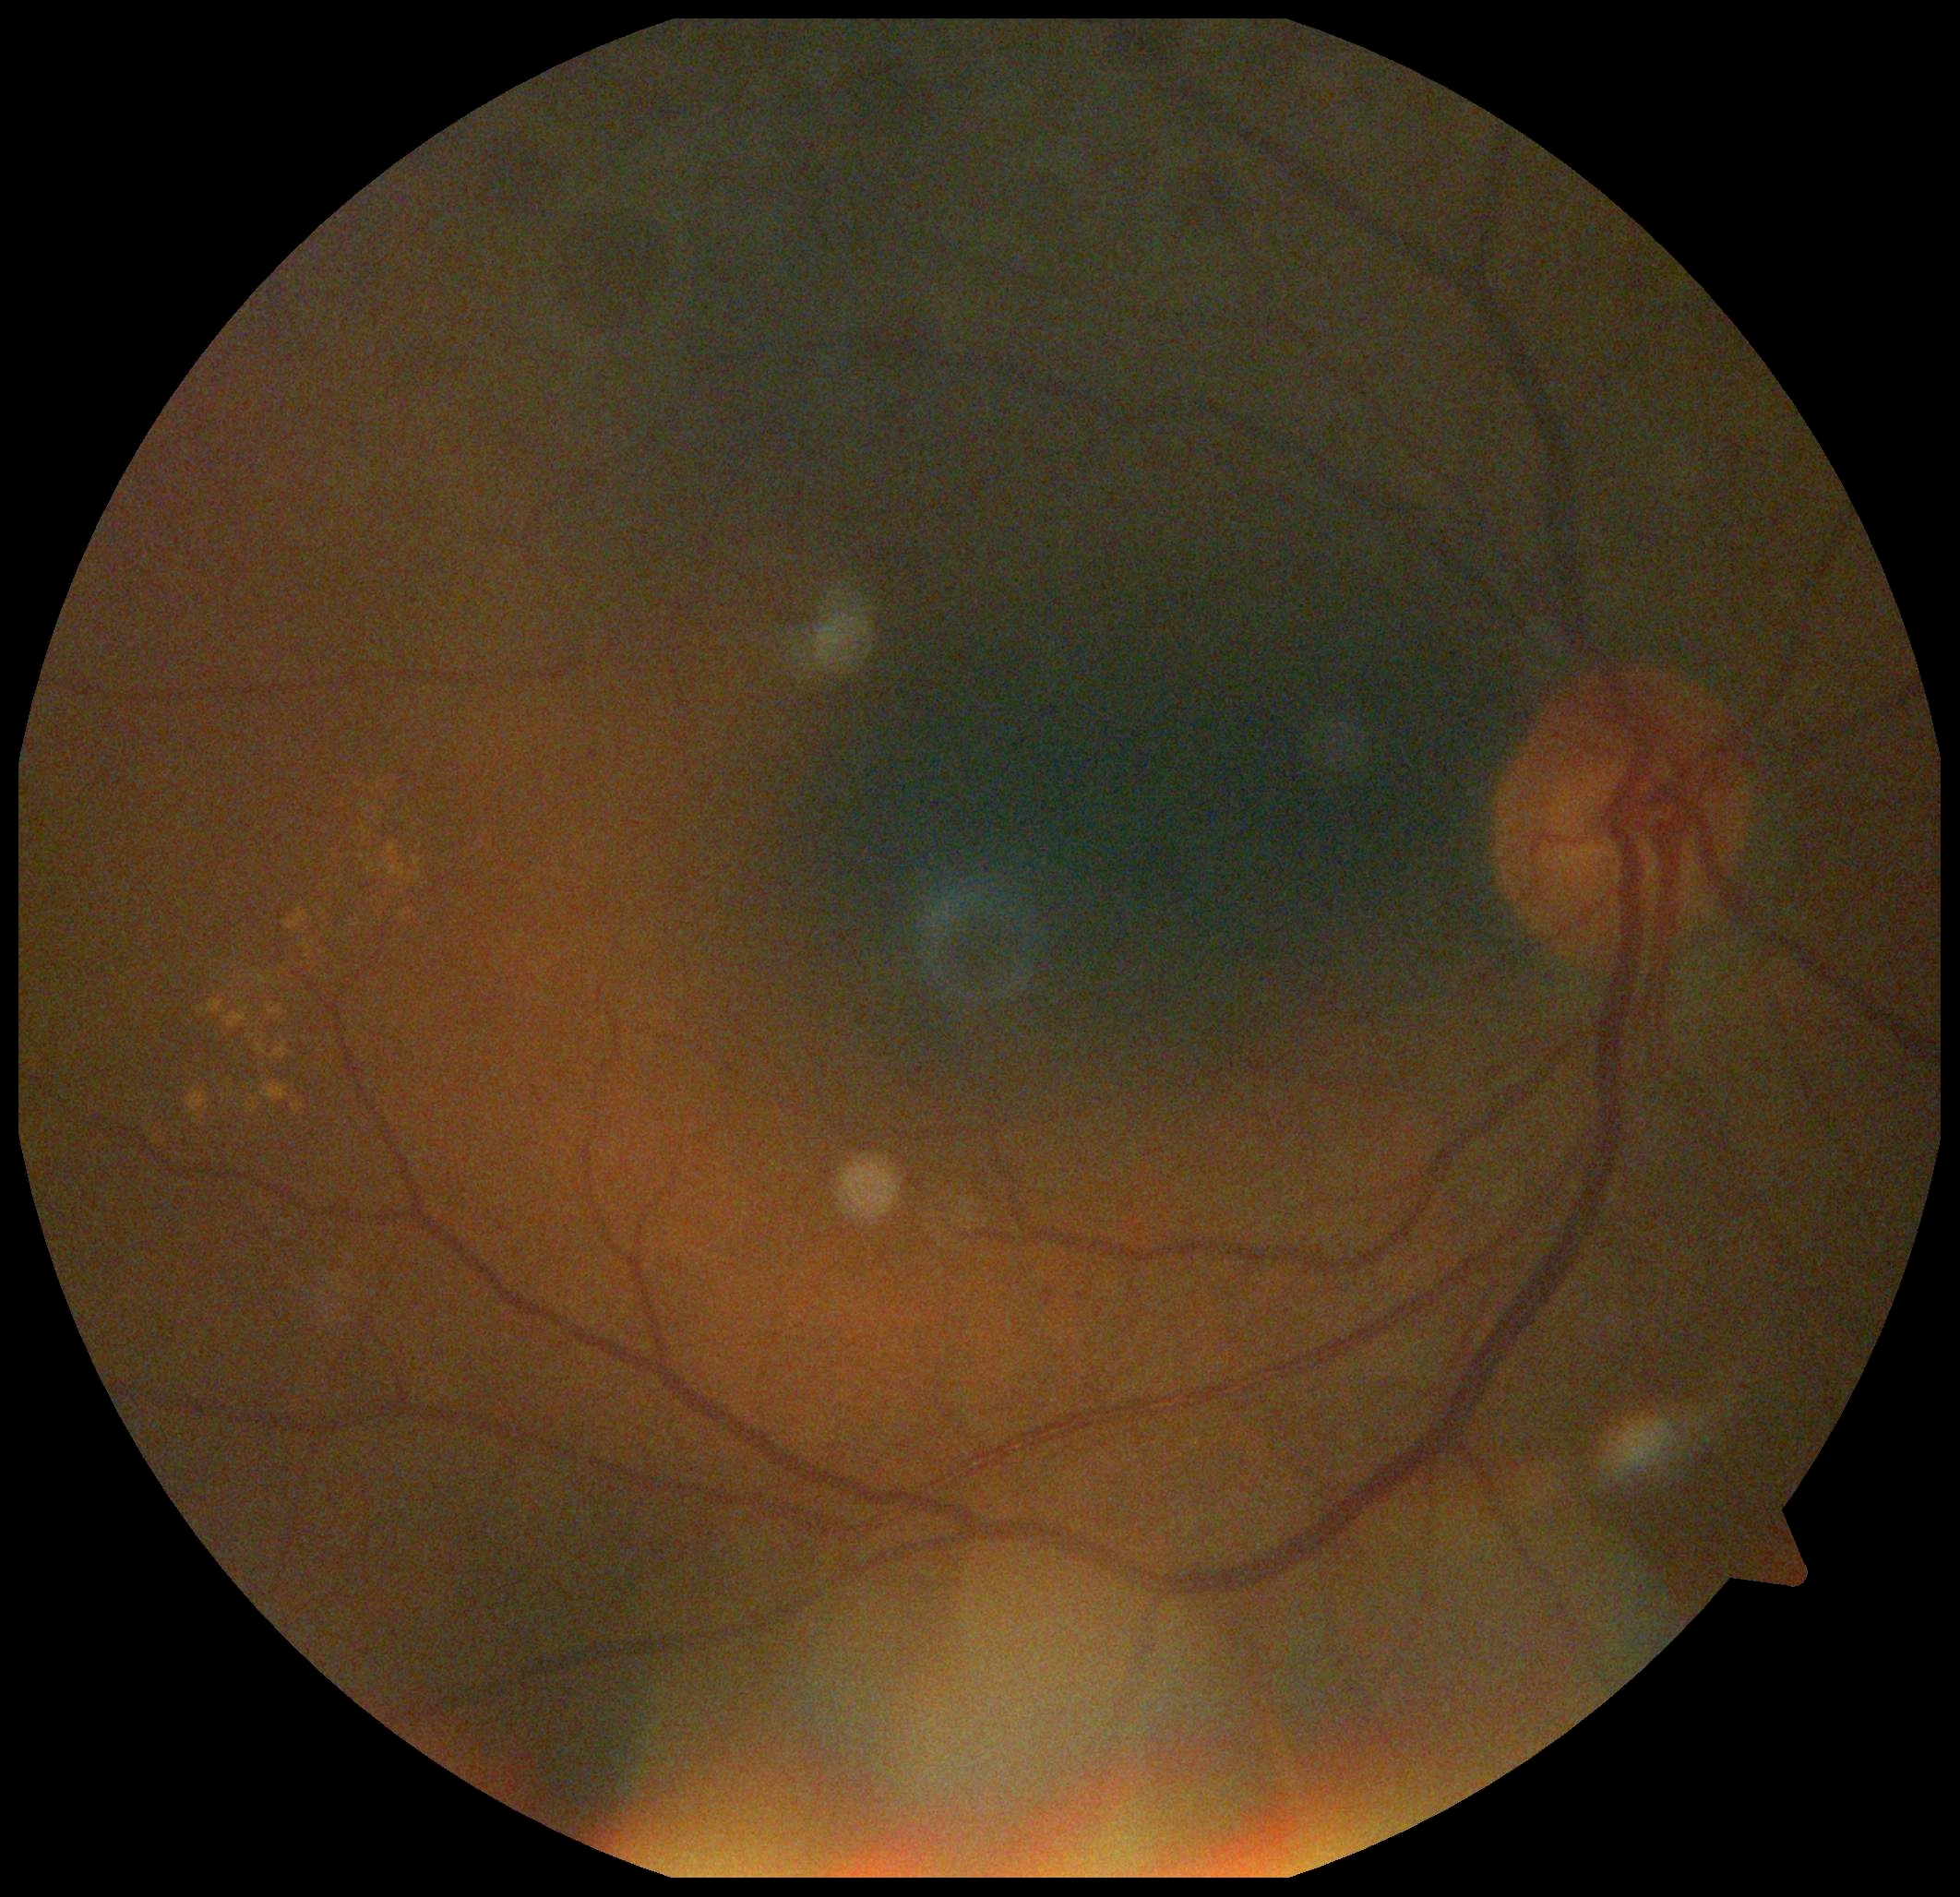
DR is 2.